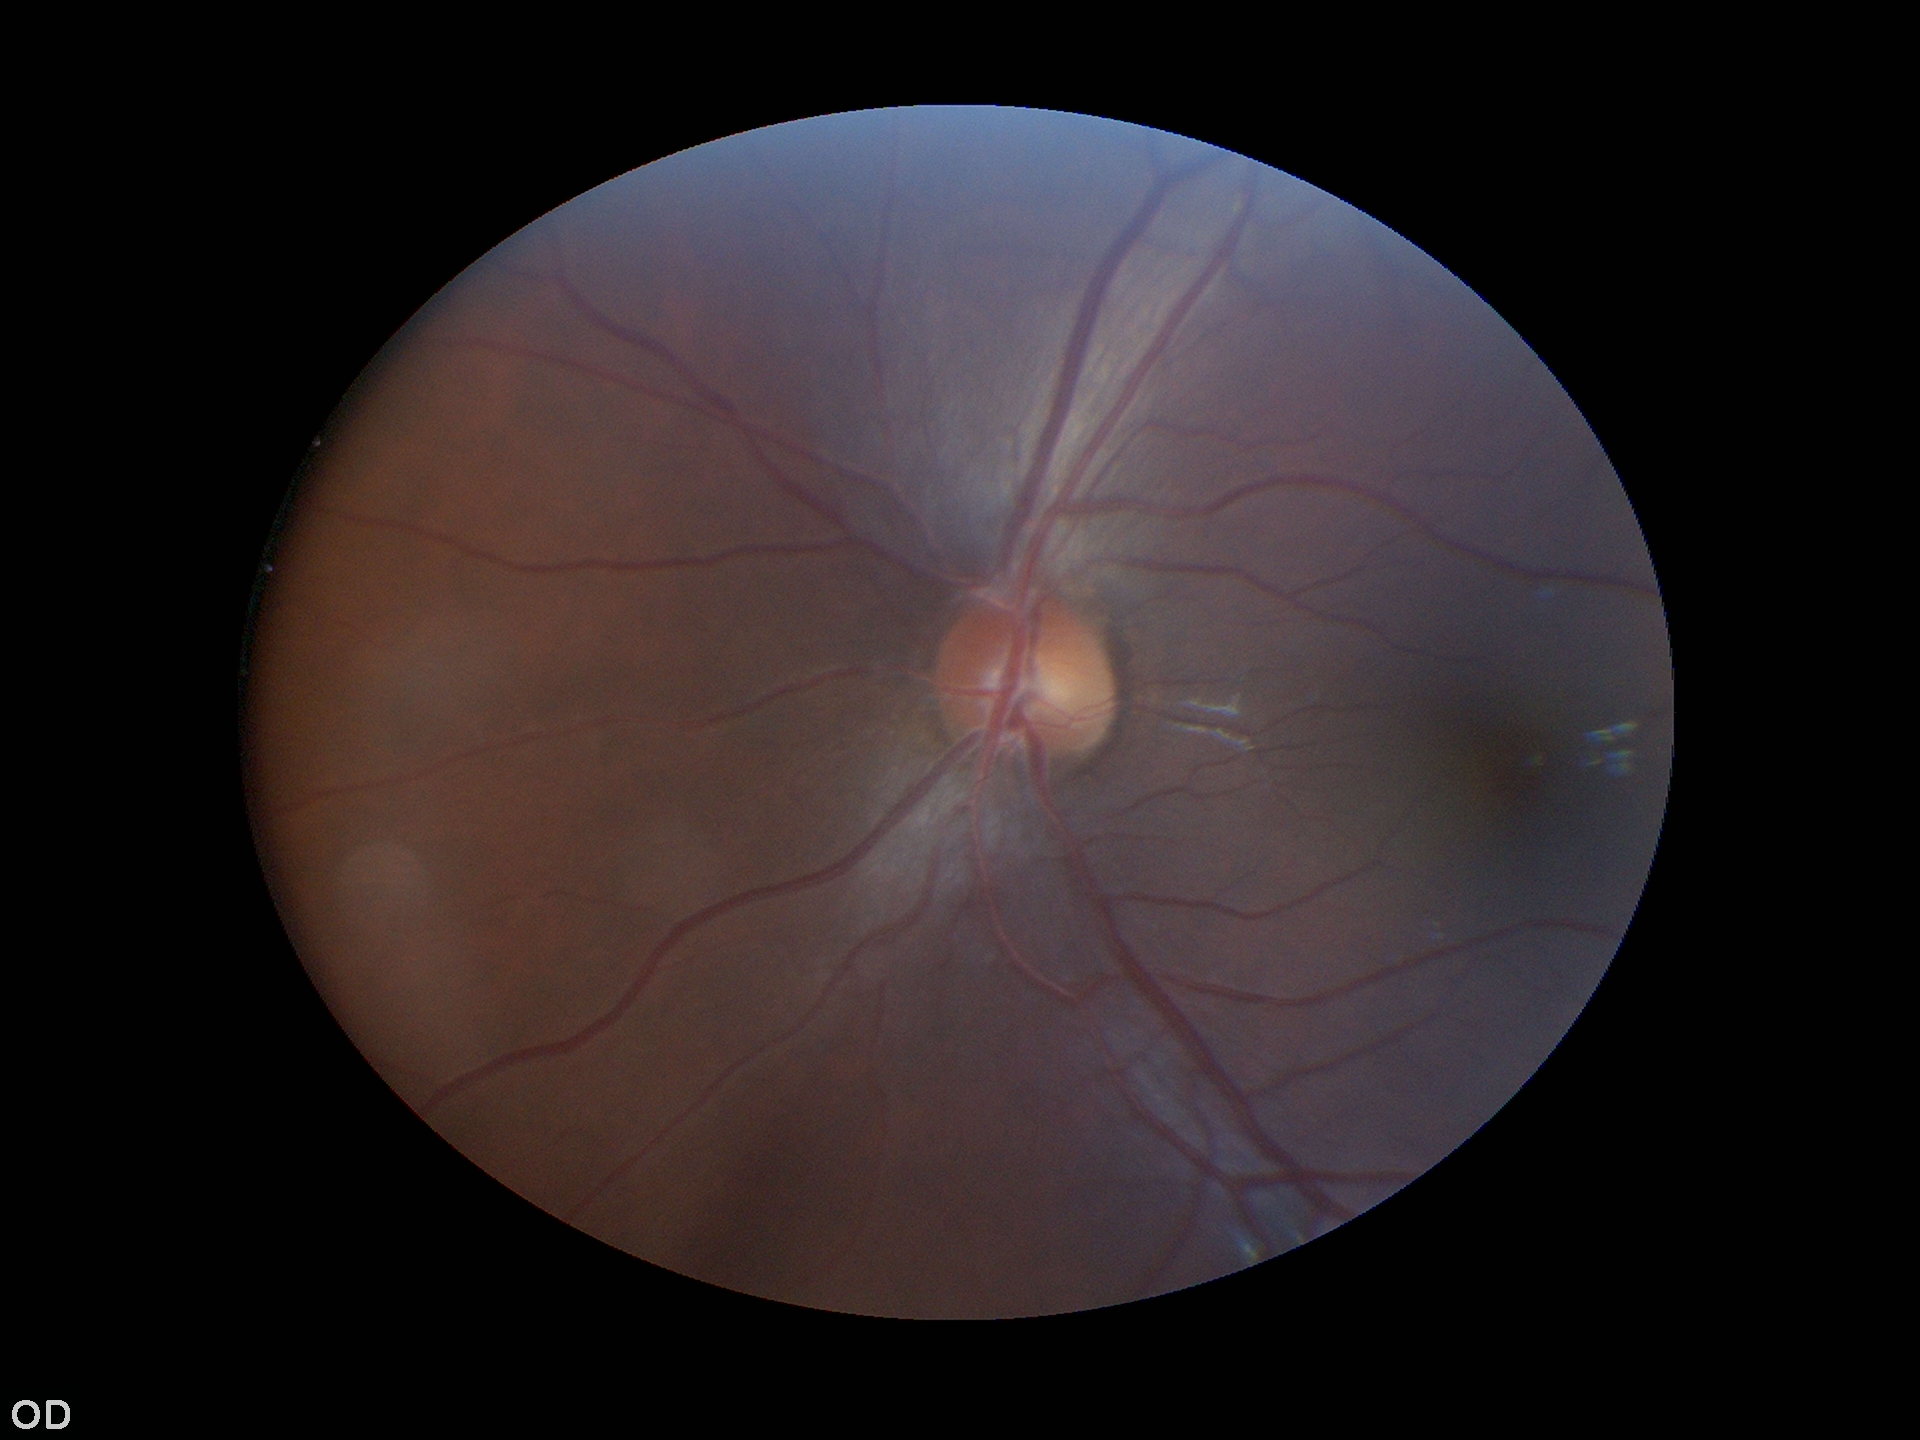

Glaucoma impression: not suspect (5/5 ophthalmologists in agreement). Vertical cup-disc ratio is 0.47. Area cup-disc ratio is 0.23. Horizontal cup-to-disc ratio: 0.50.